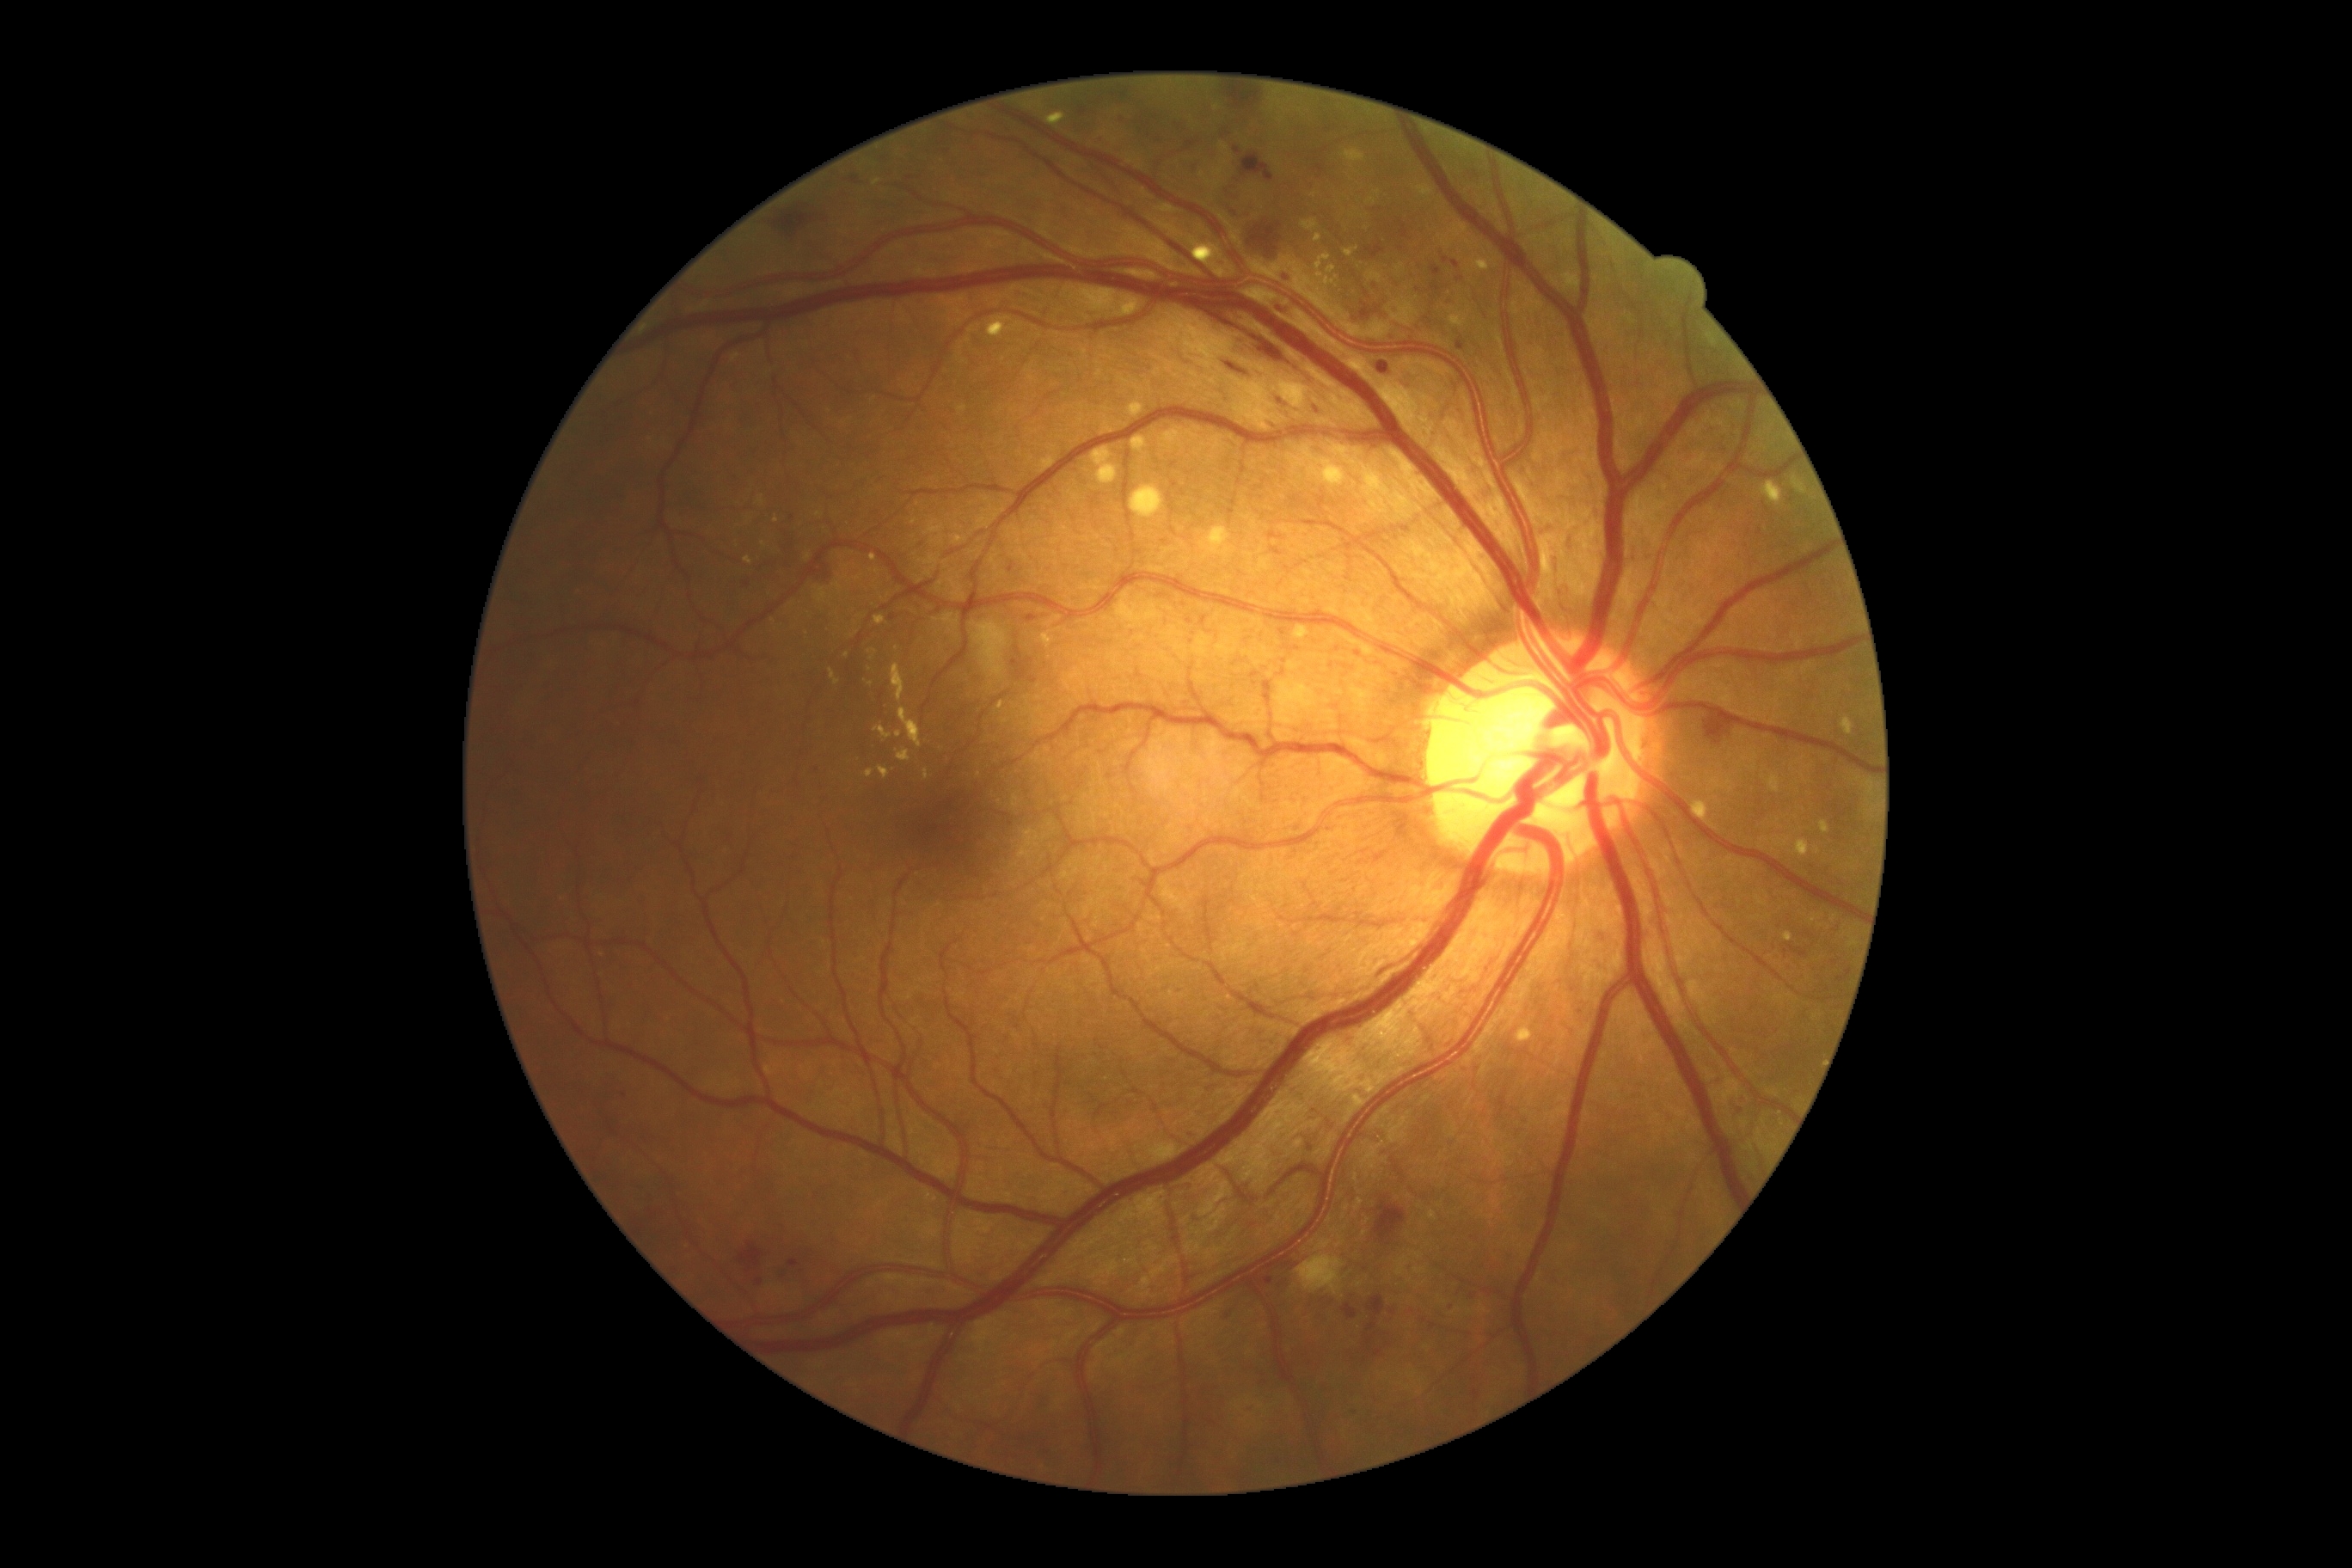 DR grade: 2/4.